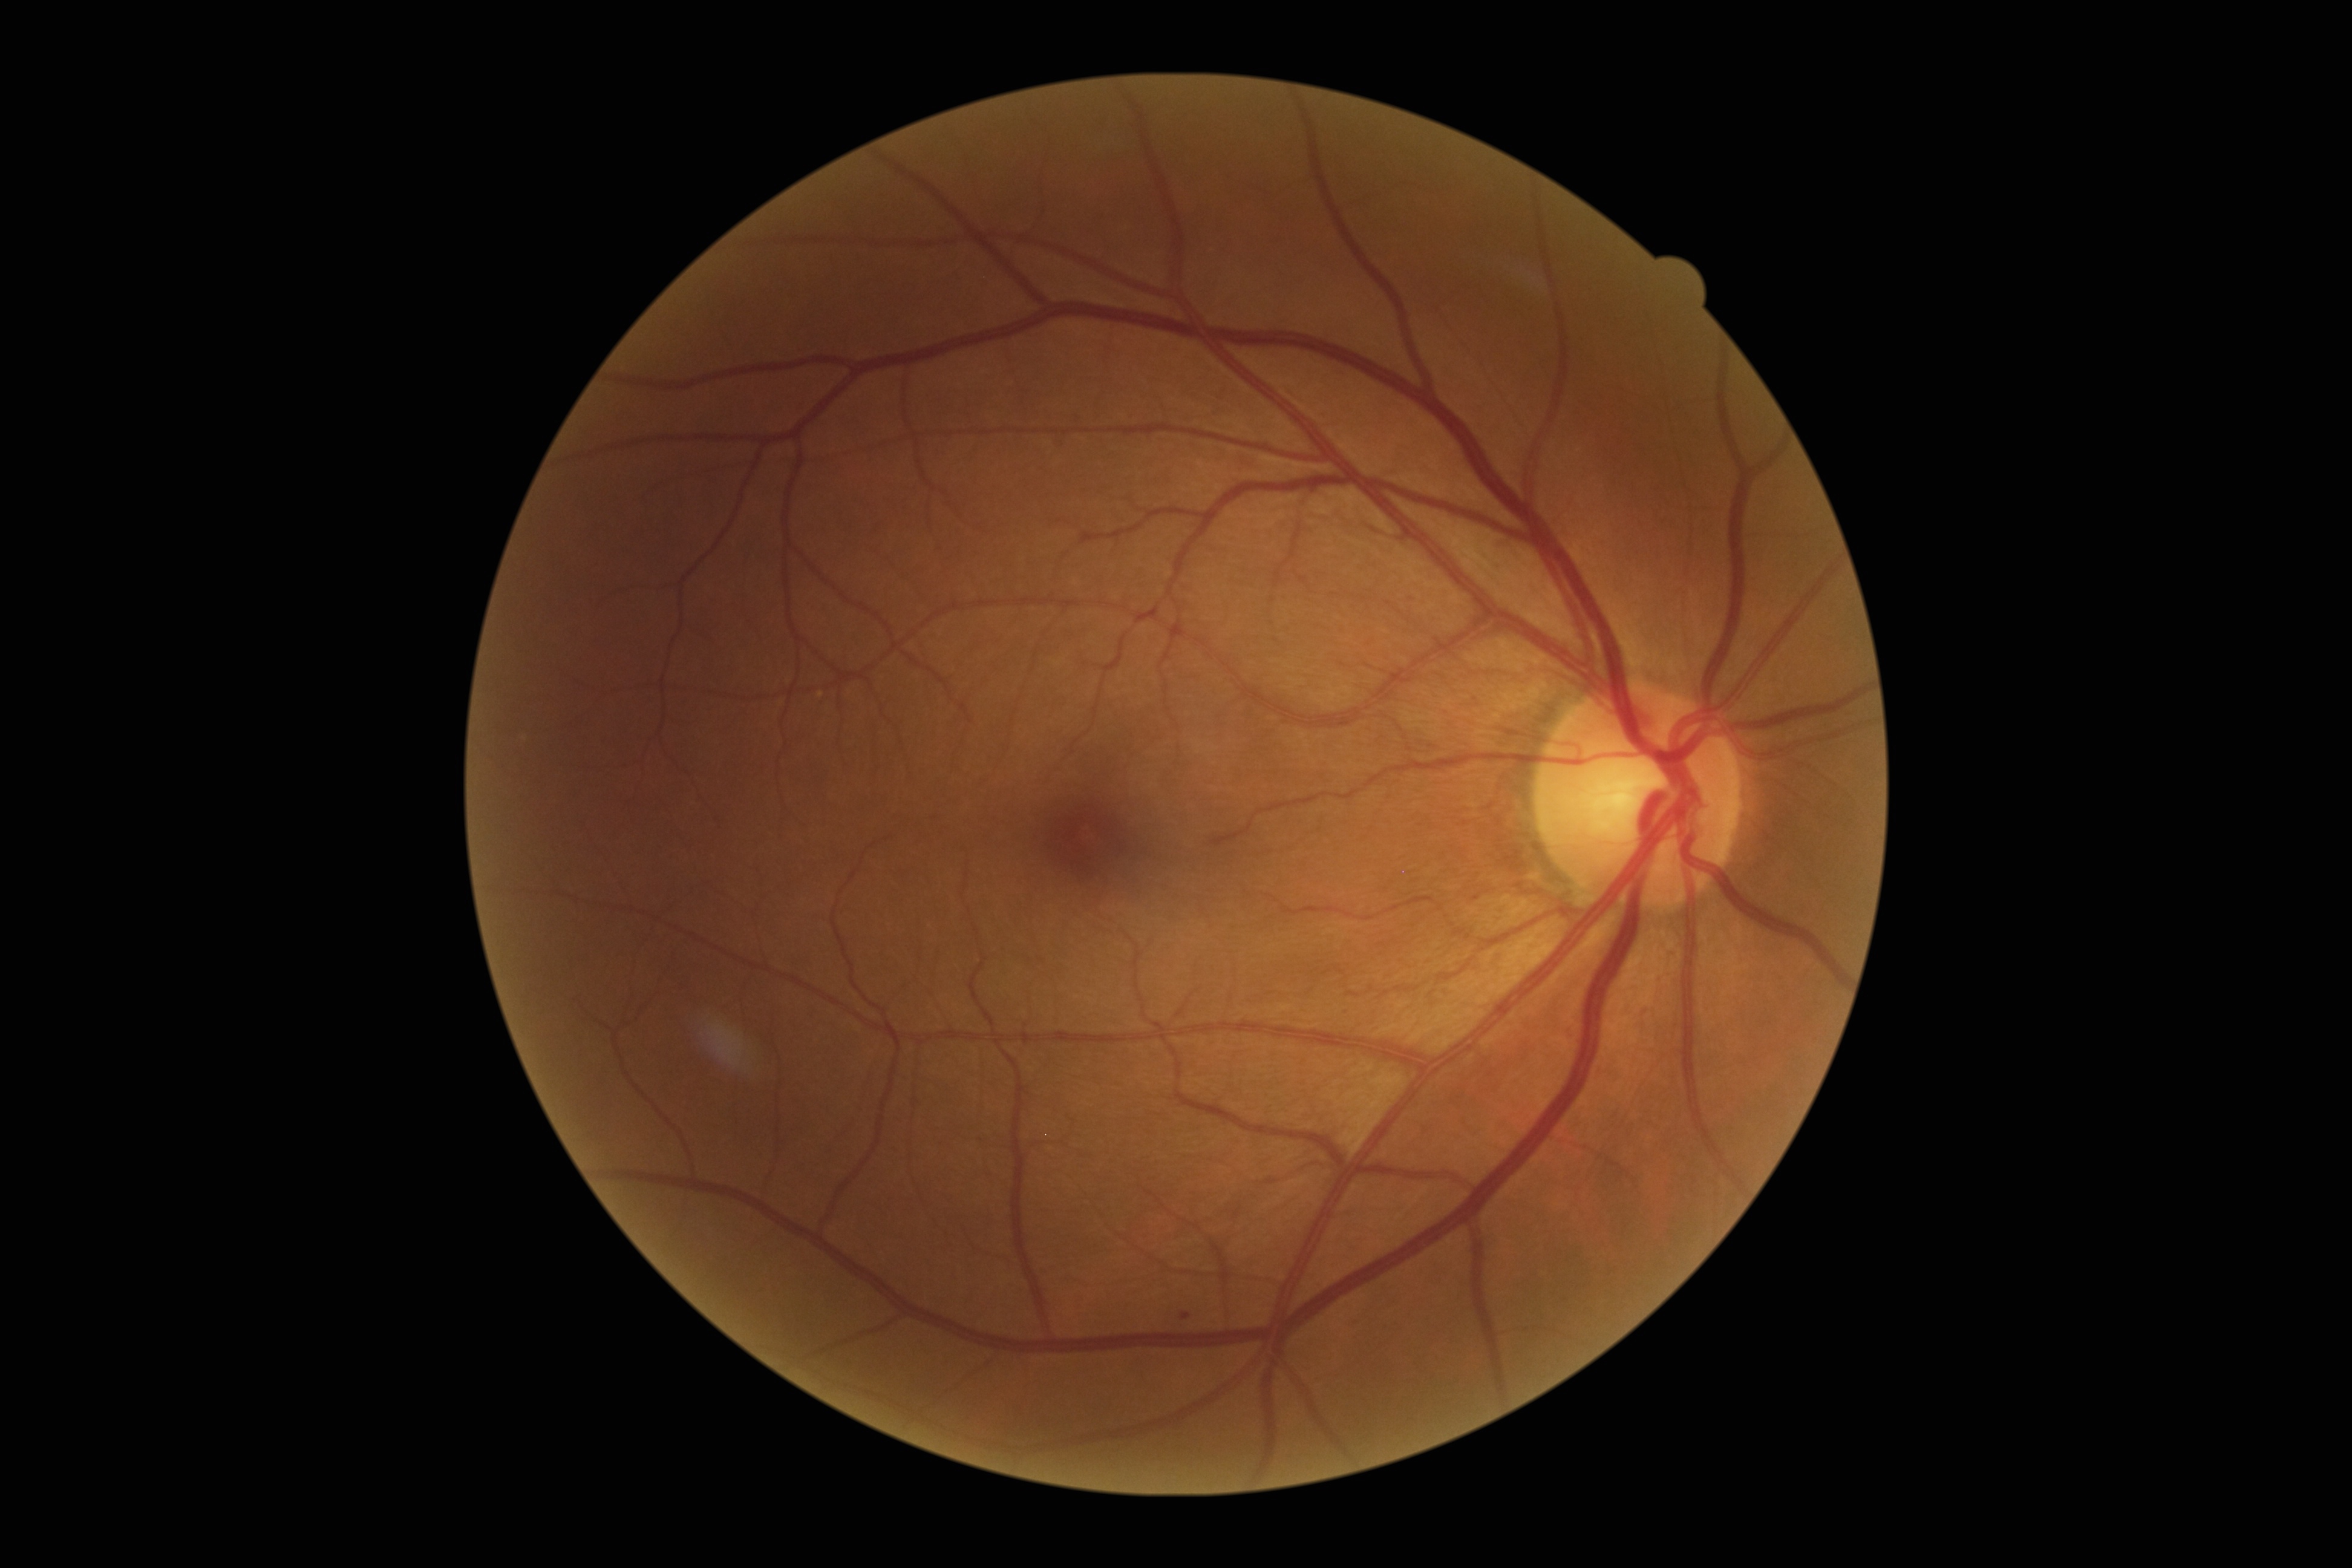

DR: mild non-proliferative diabetic retinopathy (grade 1)
SEs: none identified
EXs: none identified
HEs: none identified
MAs: l=1181, t=1312, r=1191, b=1319